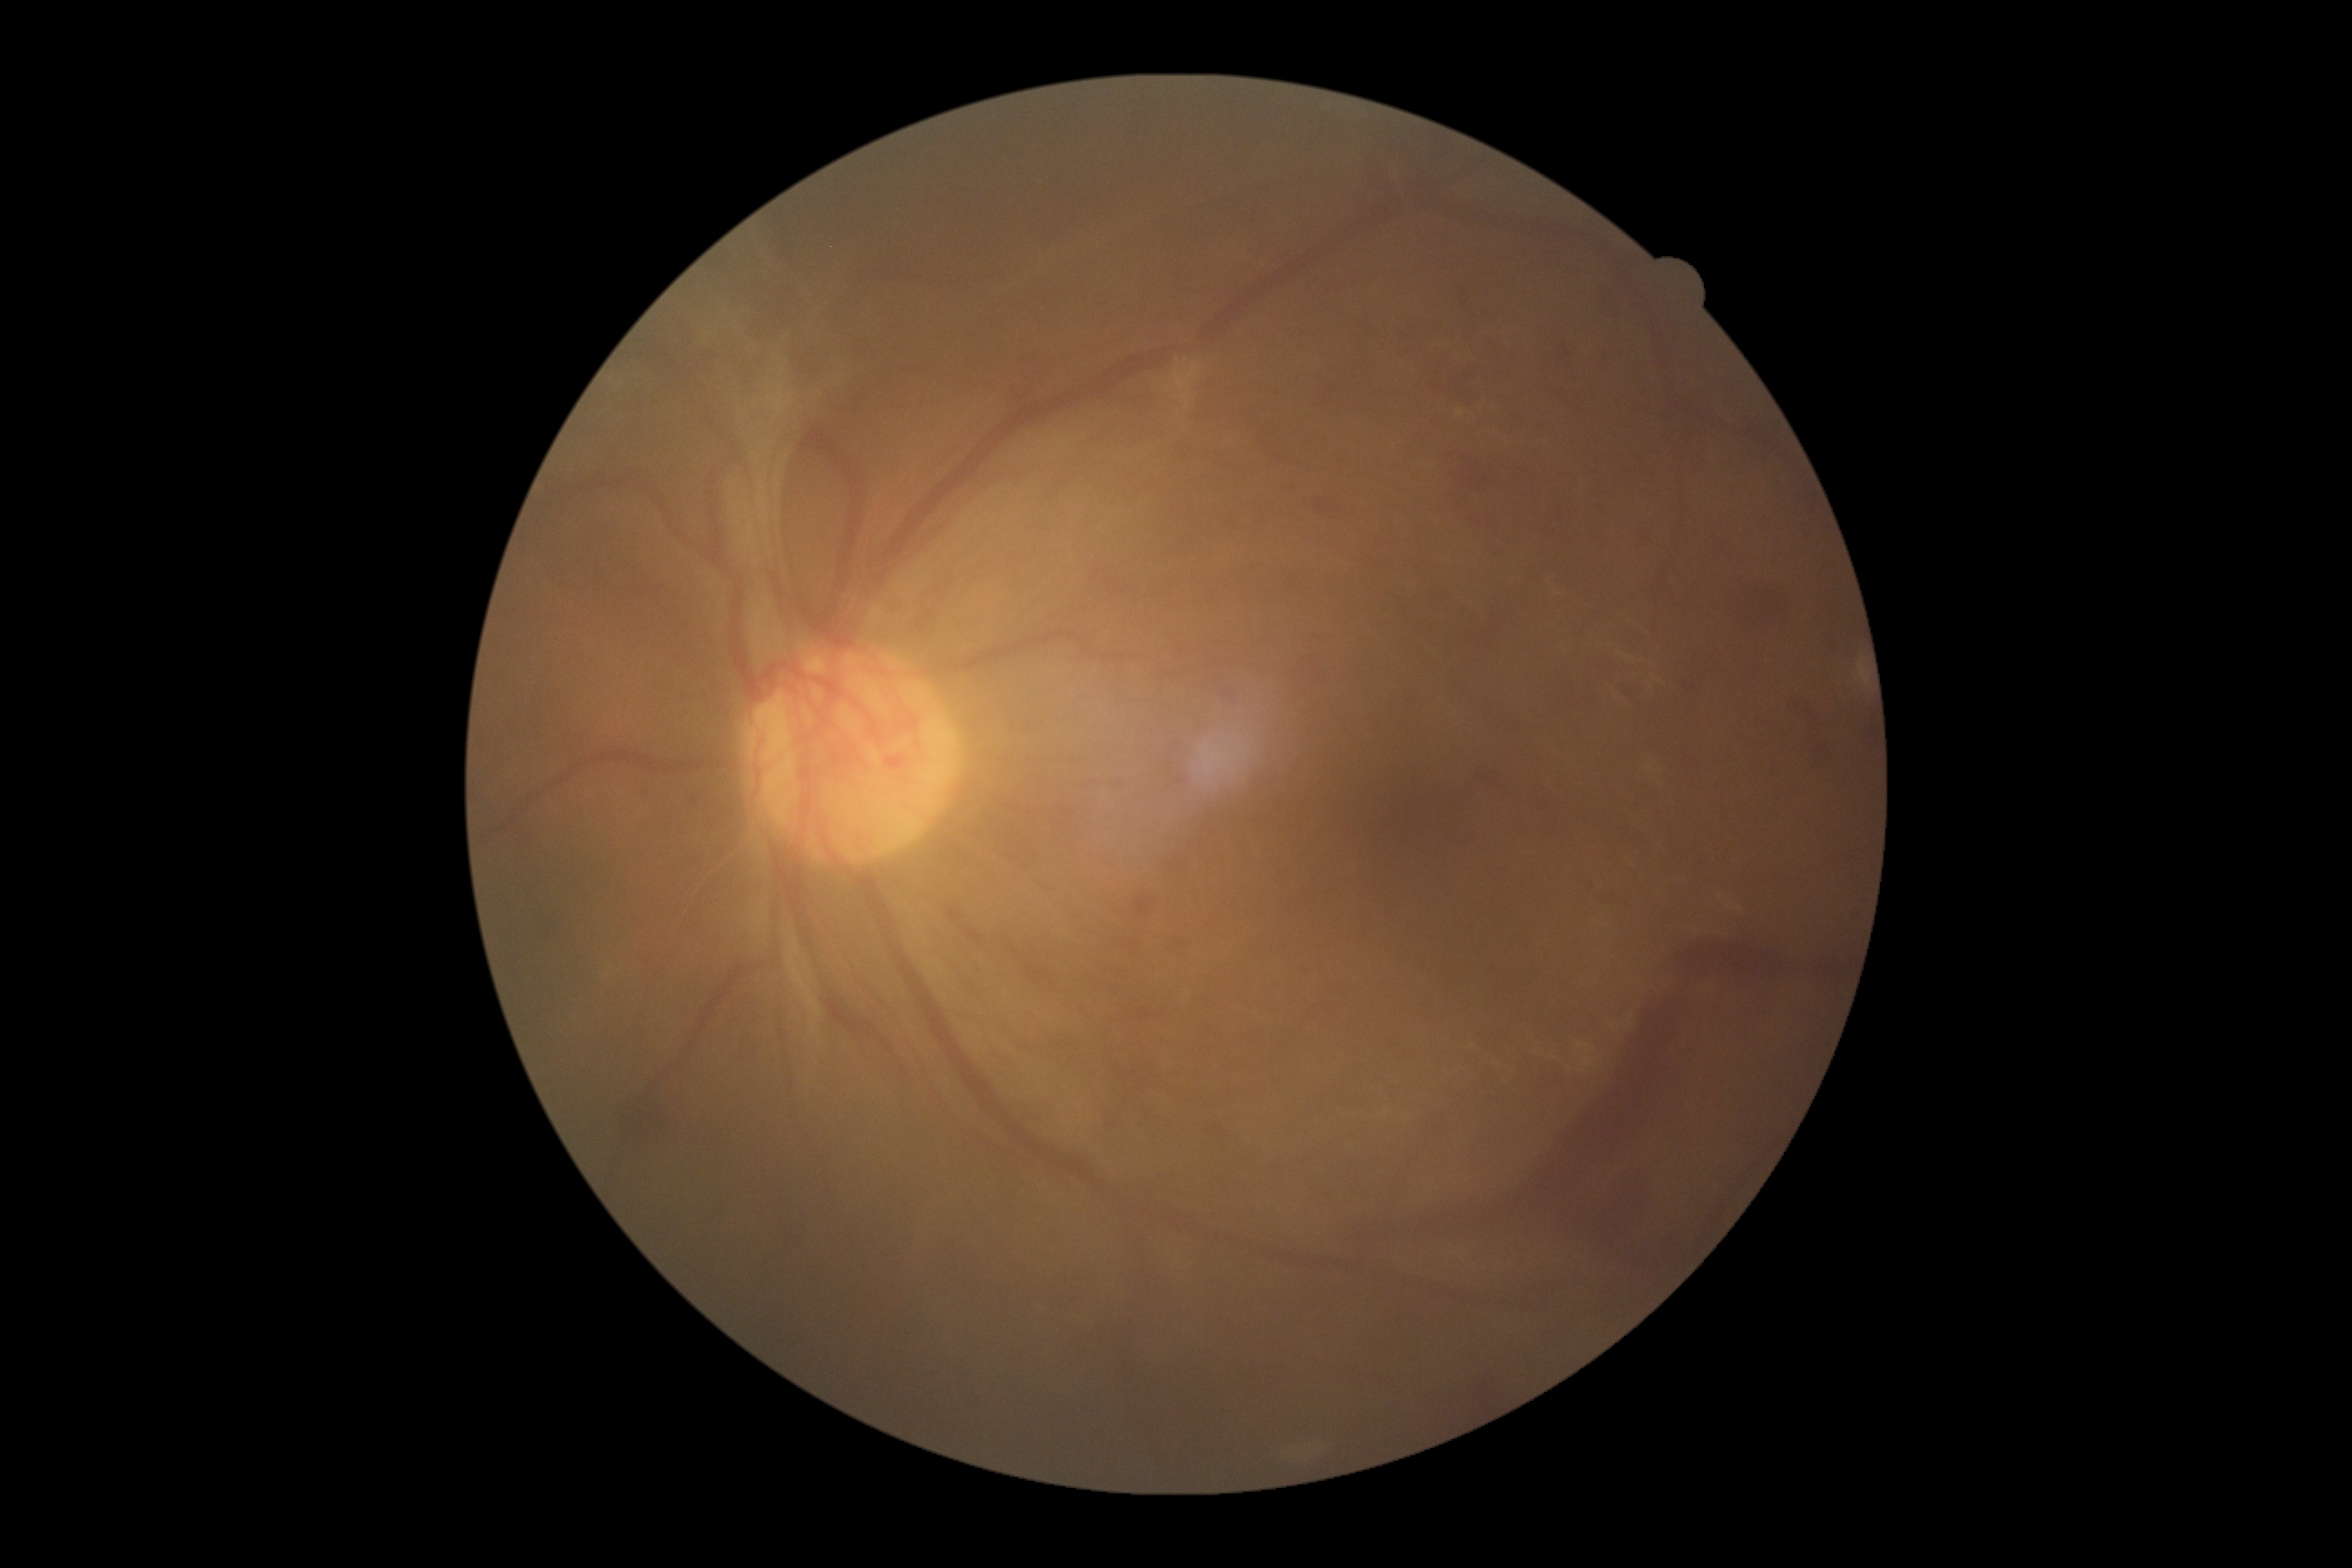

DR class: proliferative diabetic retinopathy. Diabetic retinopathy: grade 4.